Color fundus photograph:
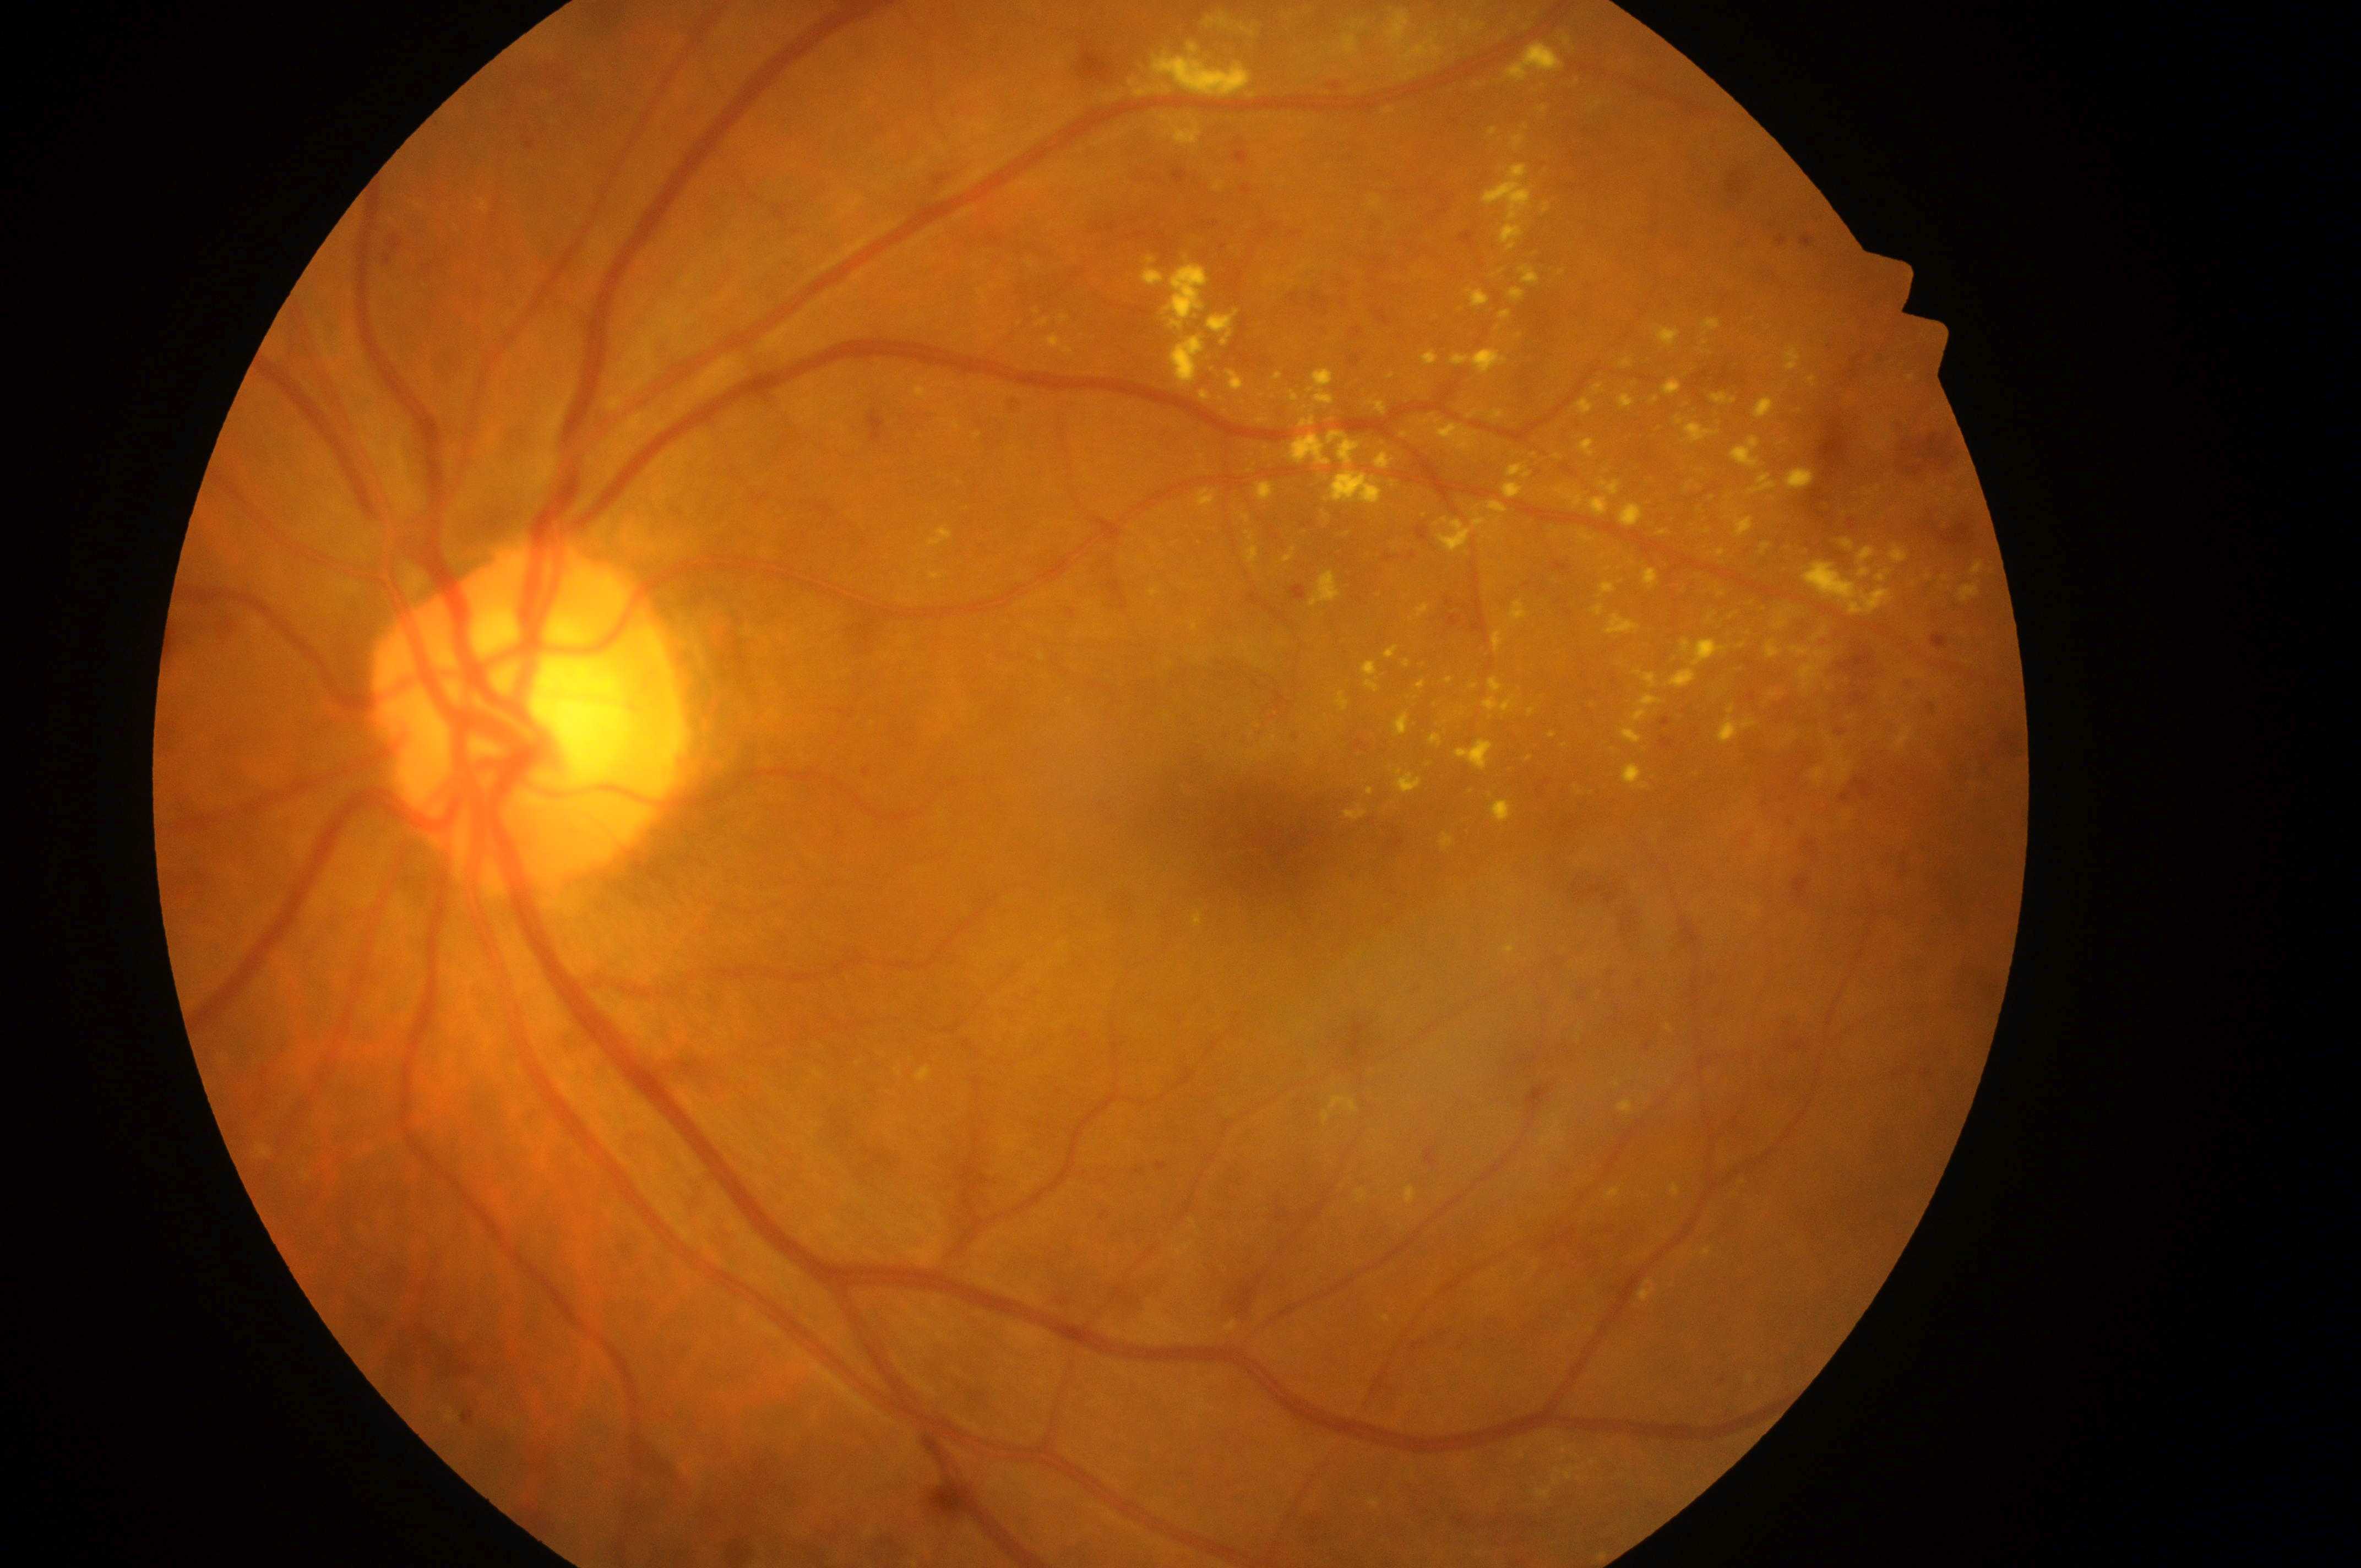

The macular center is at [1260, 833].
The optic disc center is at [513, 726].
Eye: oculus sinister.
DME grade: high risk (2).
DR class: non-proliferative diabetic retinopathy.
DR severity is moderate non-proliferative diabetic retinopathy (grade 2).